Modified Davis grading:
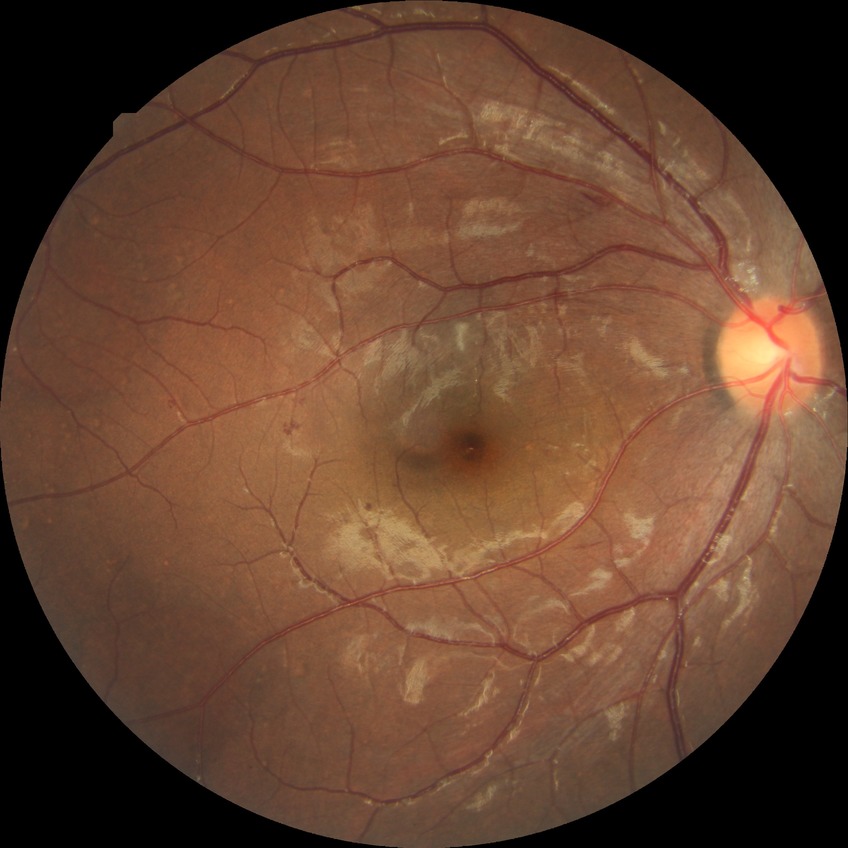
Disease class: non-proliferative diabetic retinopathy.
Diabetic retinopathy (DR): simple diabetic retinopathy (SDR).